2212 x 1661 pixels. Axial length (AL): 26.04 mm. Color fundus photograph. Centered on the optic disc. Undilated pupil. Topcon TRC-NW400. FOV: 30 degrees. Male patient:
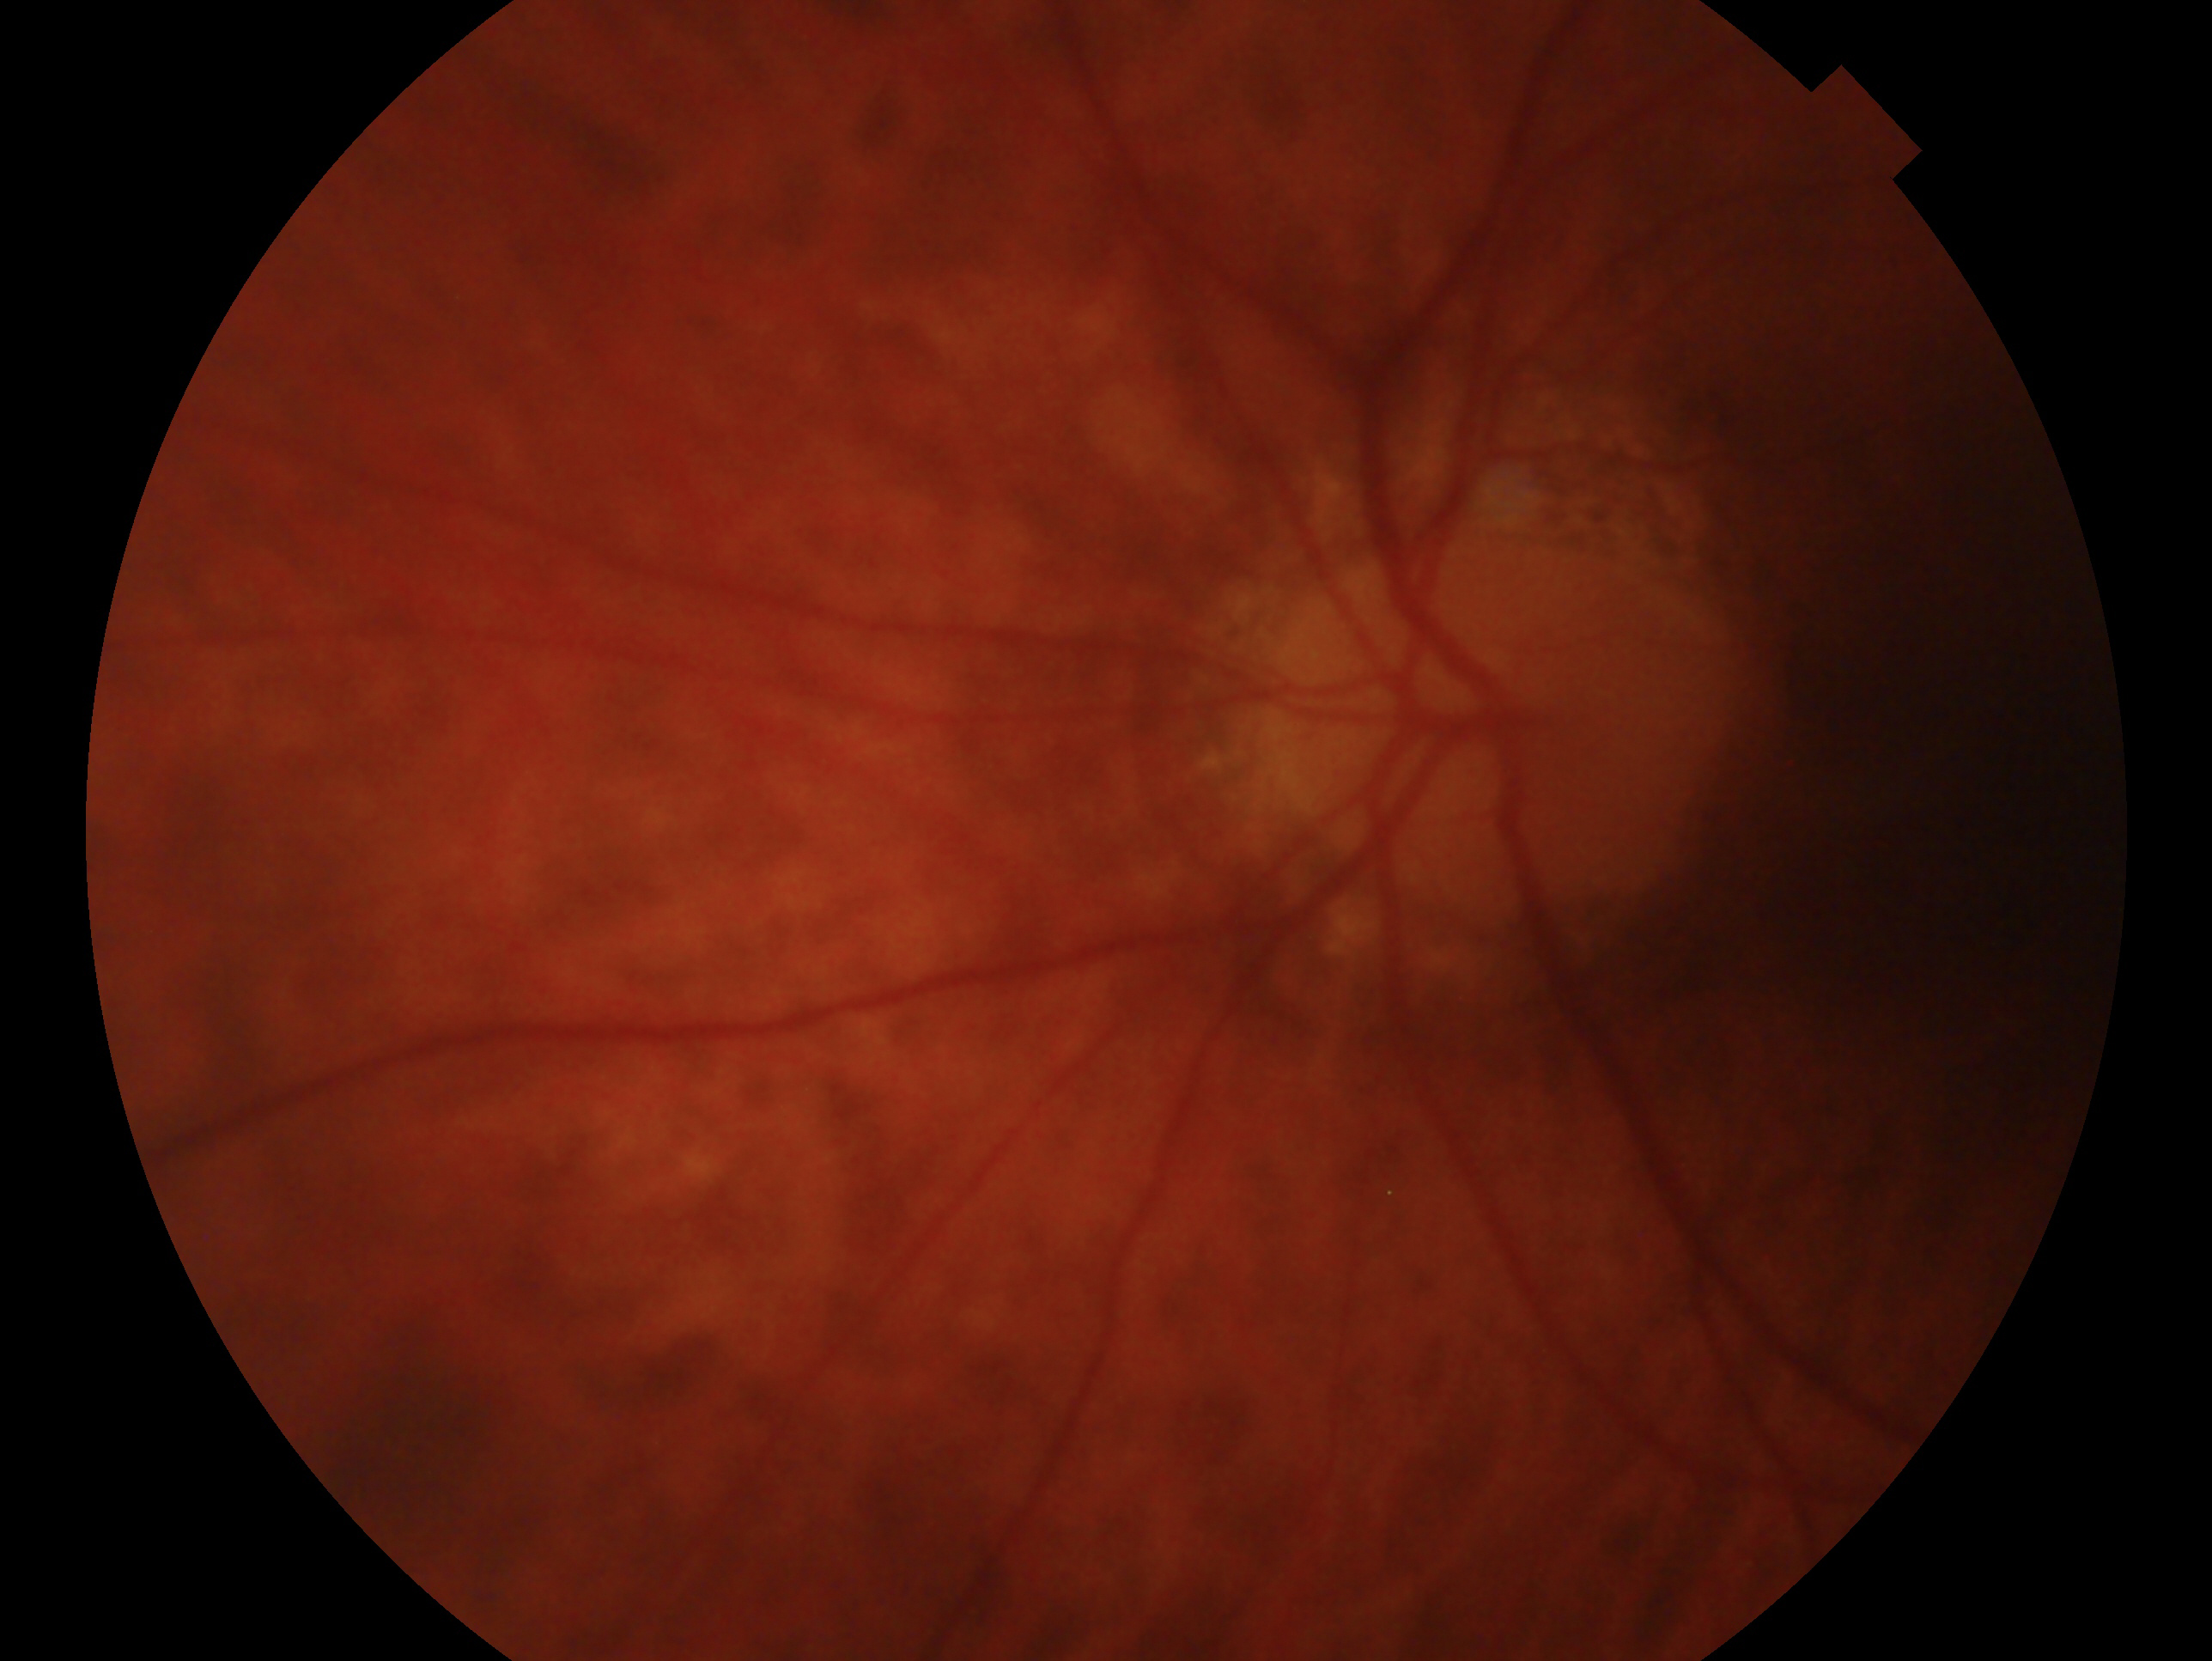
glaucoma assessment=consistent with glaucoma; laterality=left eye.